45 degree fundus photograph:
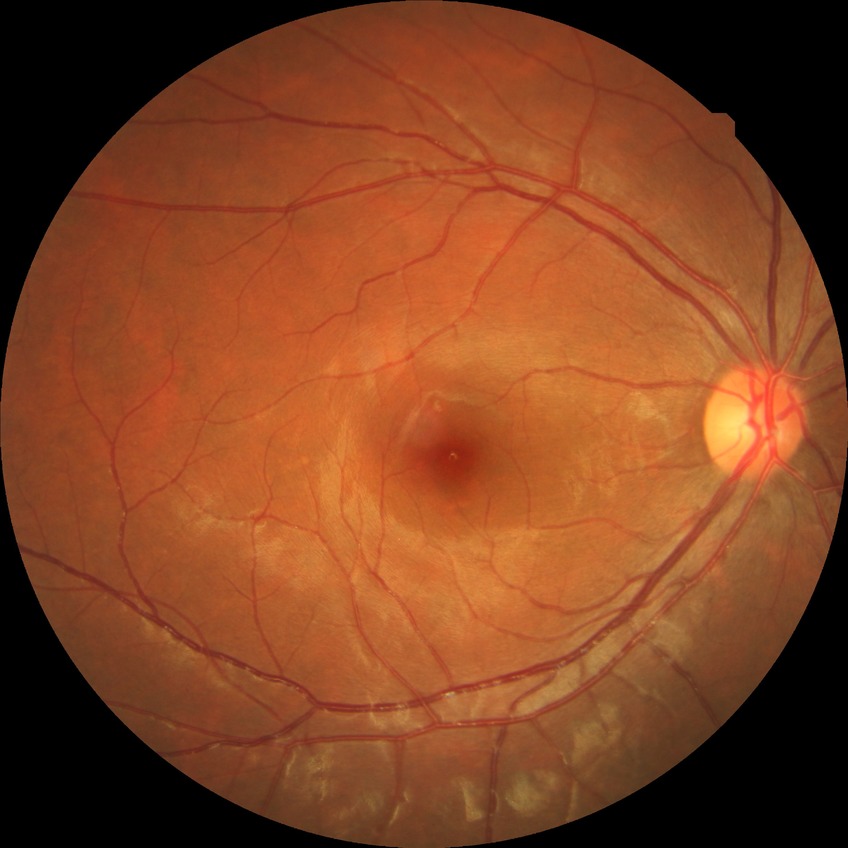
Diabetic retinopathy (DR): NDR (no diabetic retinopathy).